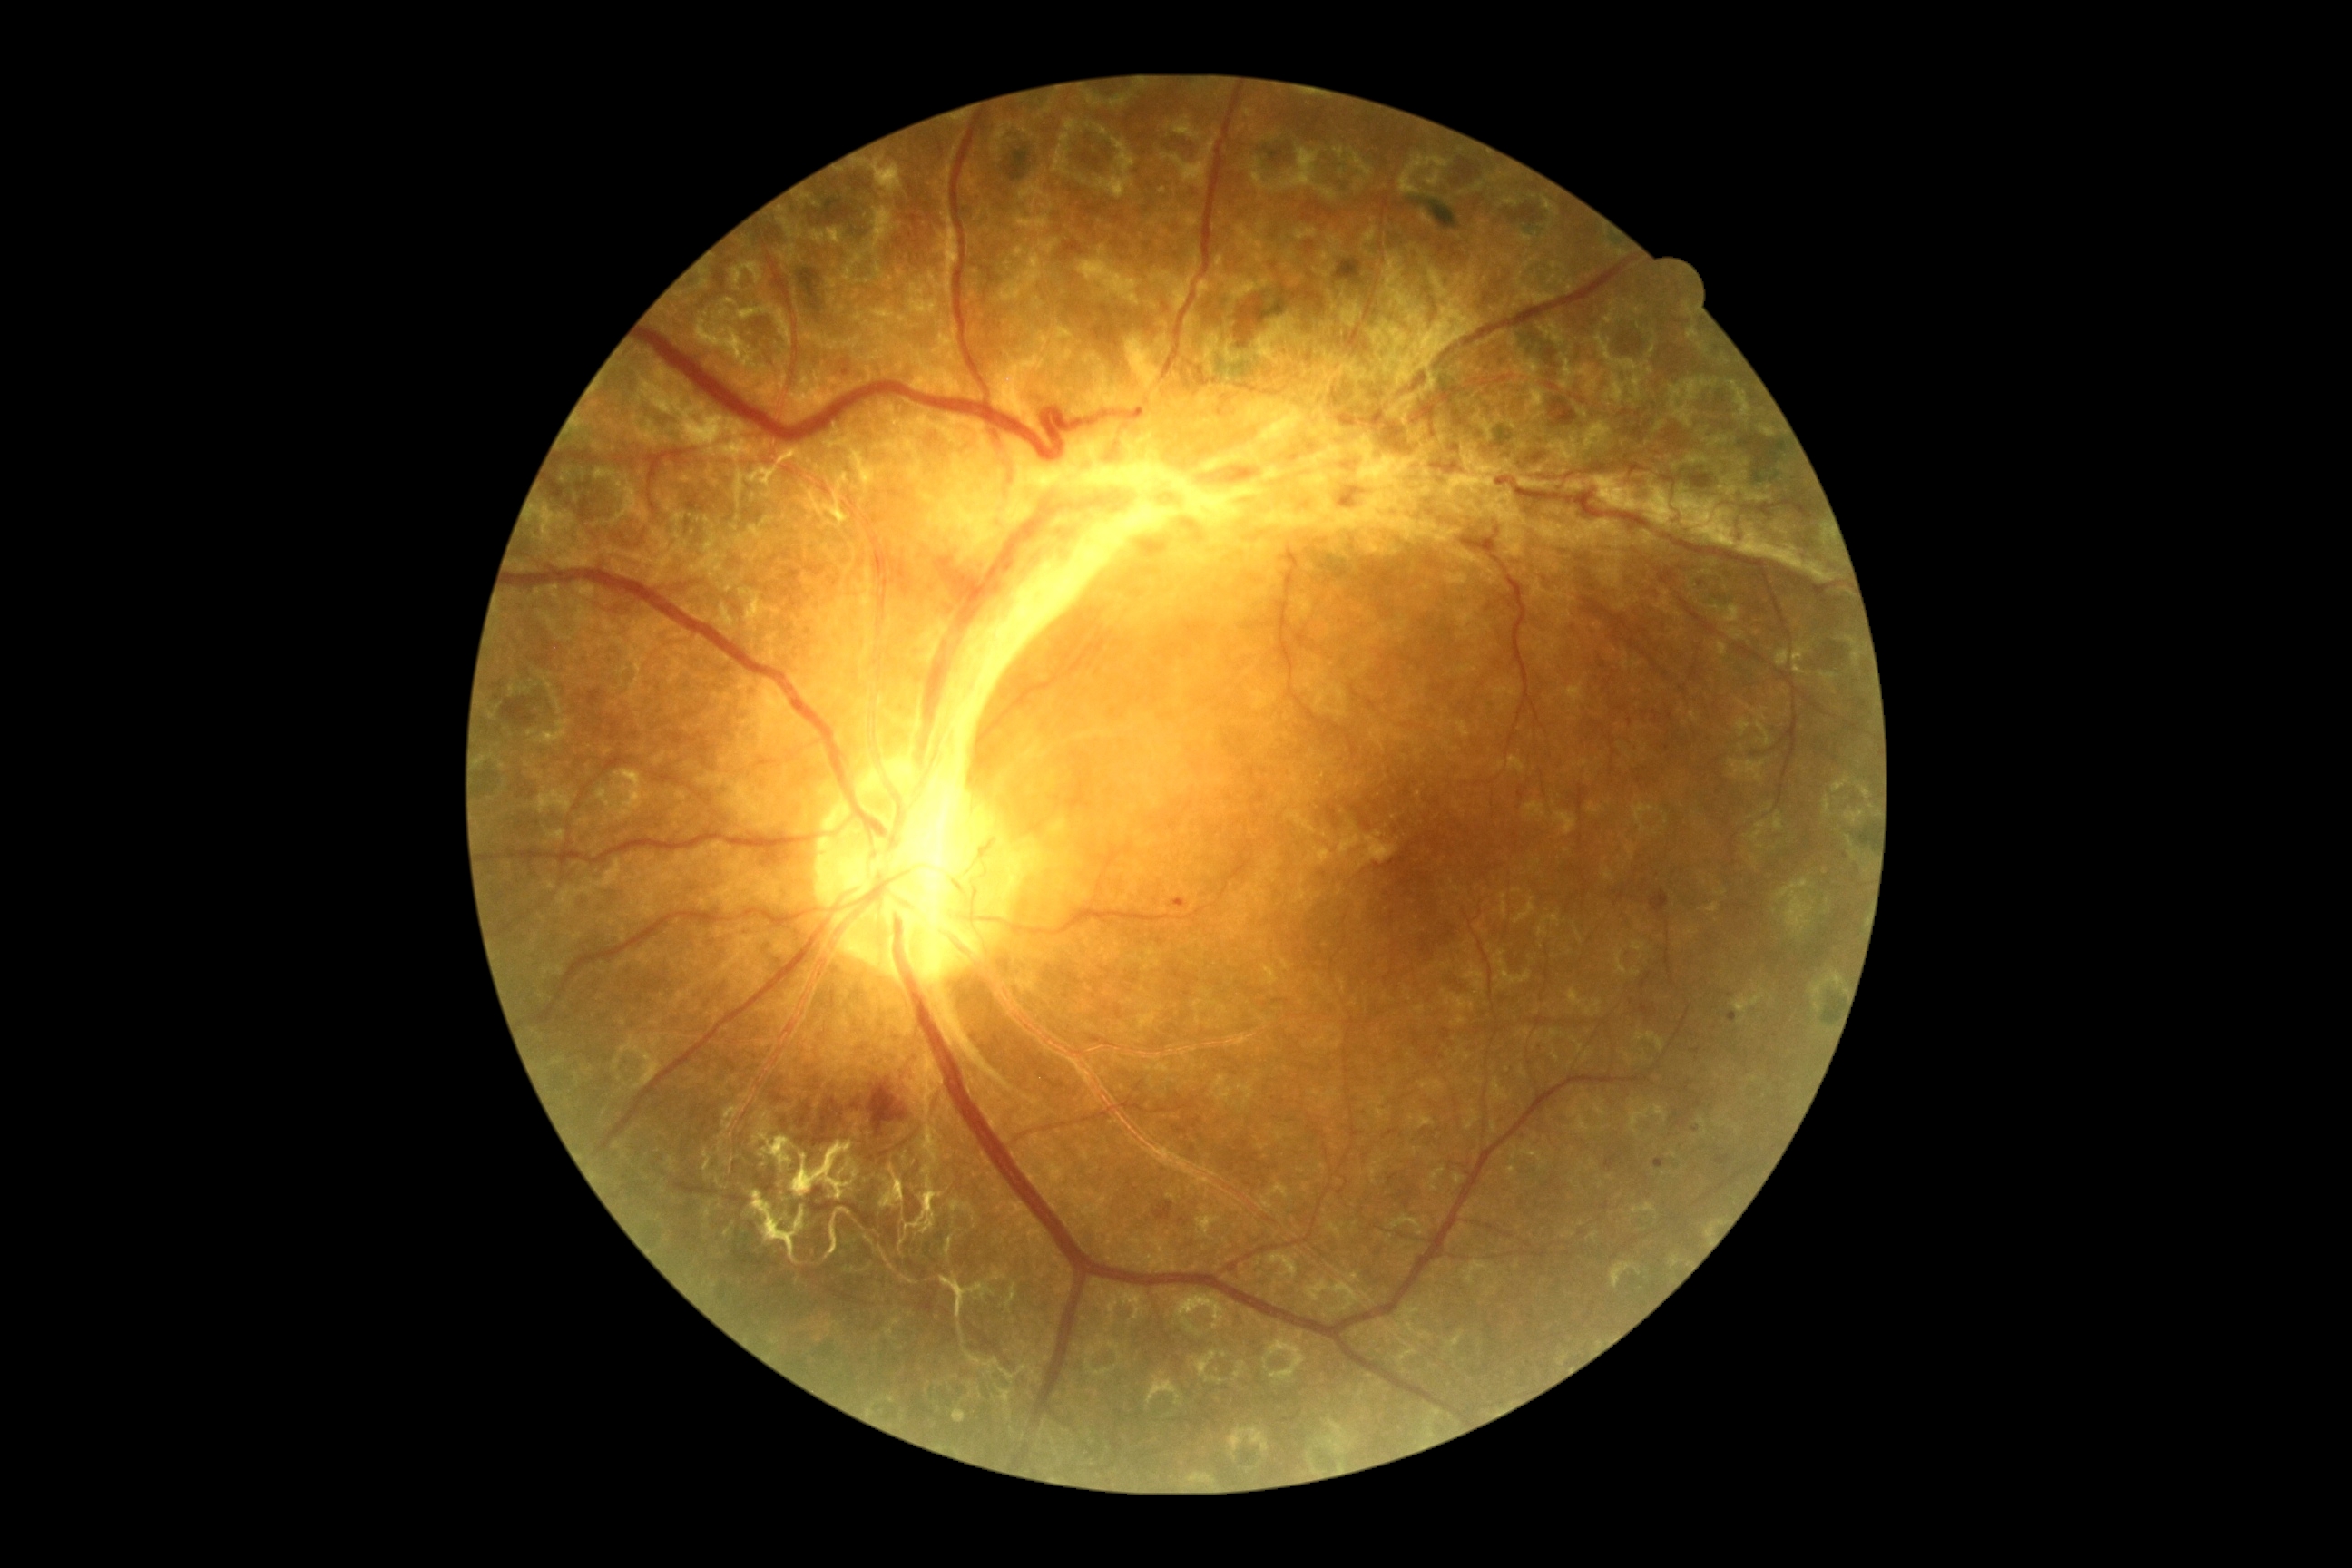

Diabetic retinopathy grade is 4 — neovascularization and/or vitreous/pre-retinal hemorrhage.